Image size 240x240, centered on the optic disc — 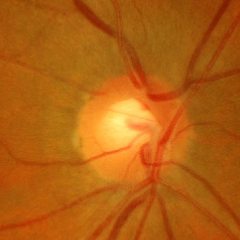 Optic nerve head appearance consistent with no glaucomatous changes.